Color fundus image, 2352 x 1568 pixels:
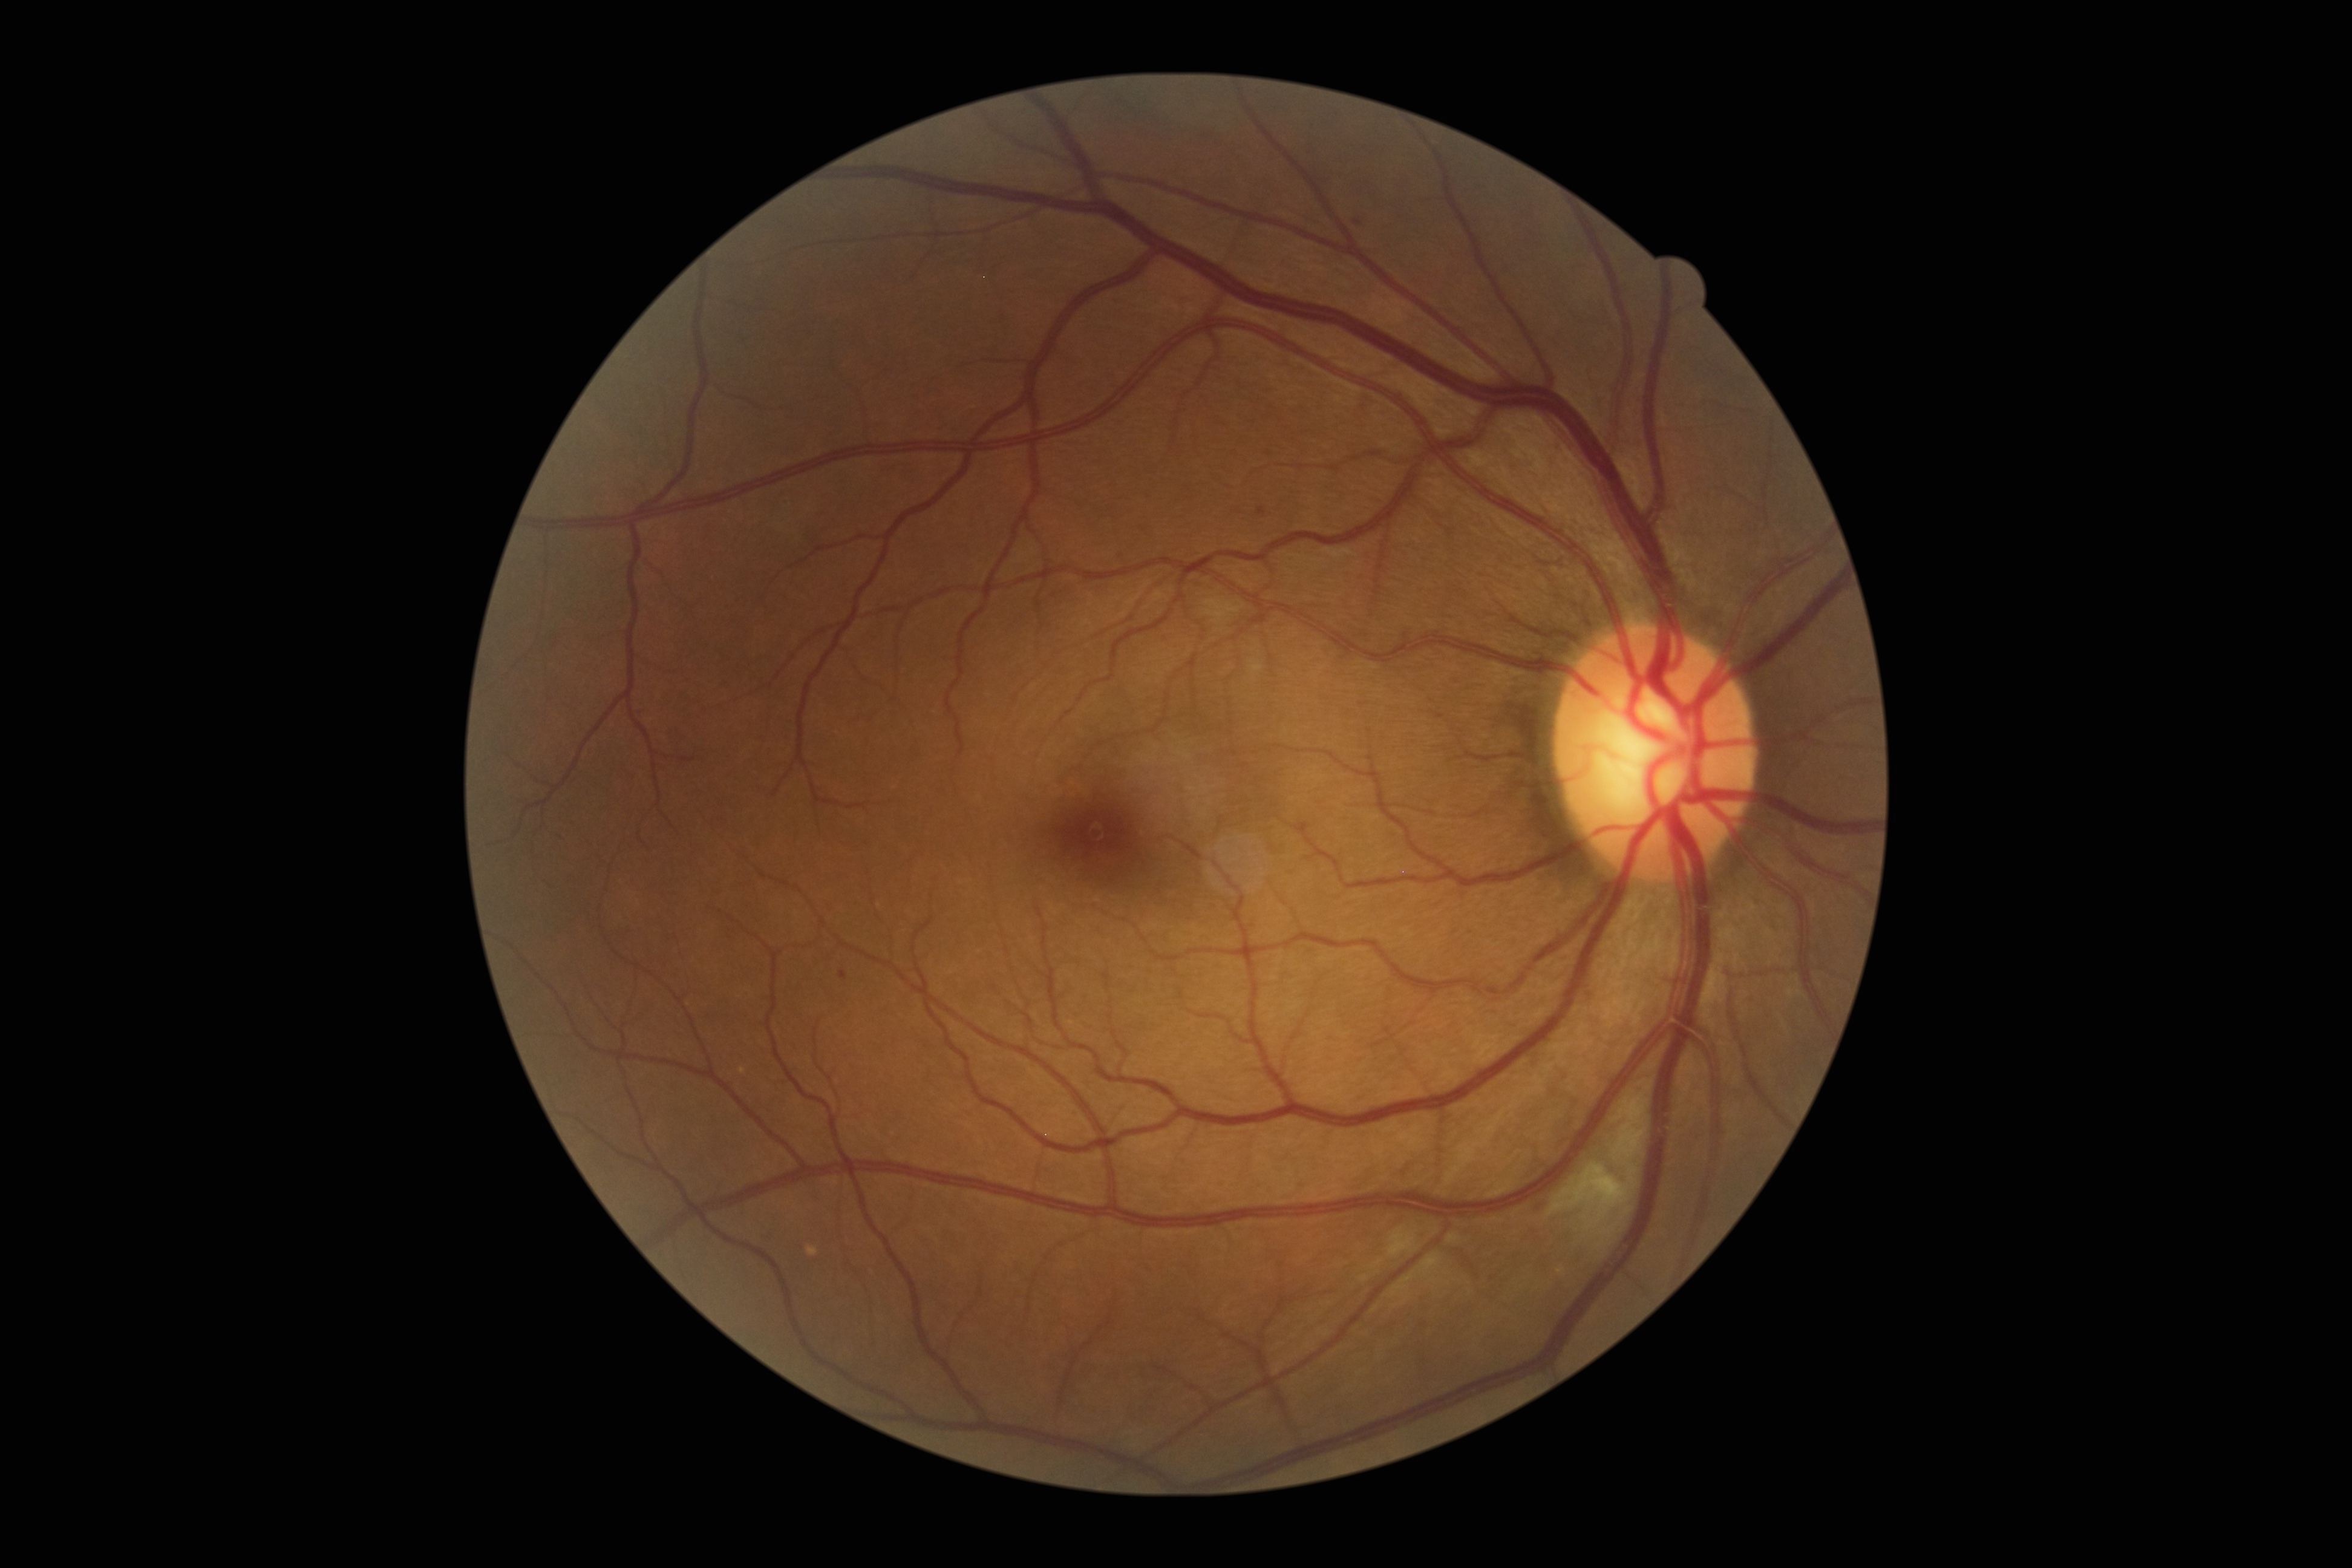

DR severity is 2/4.